45-degree field of view — 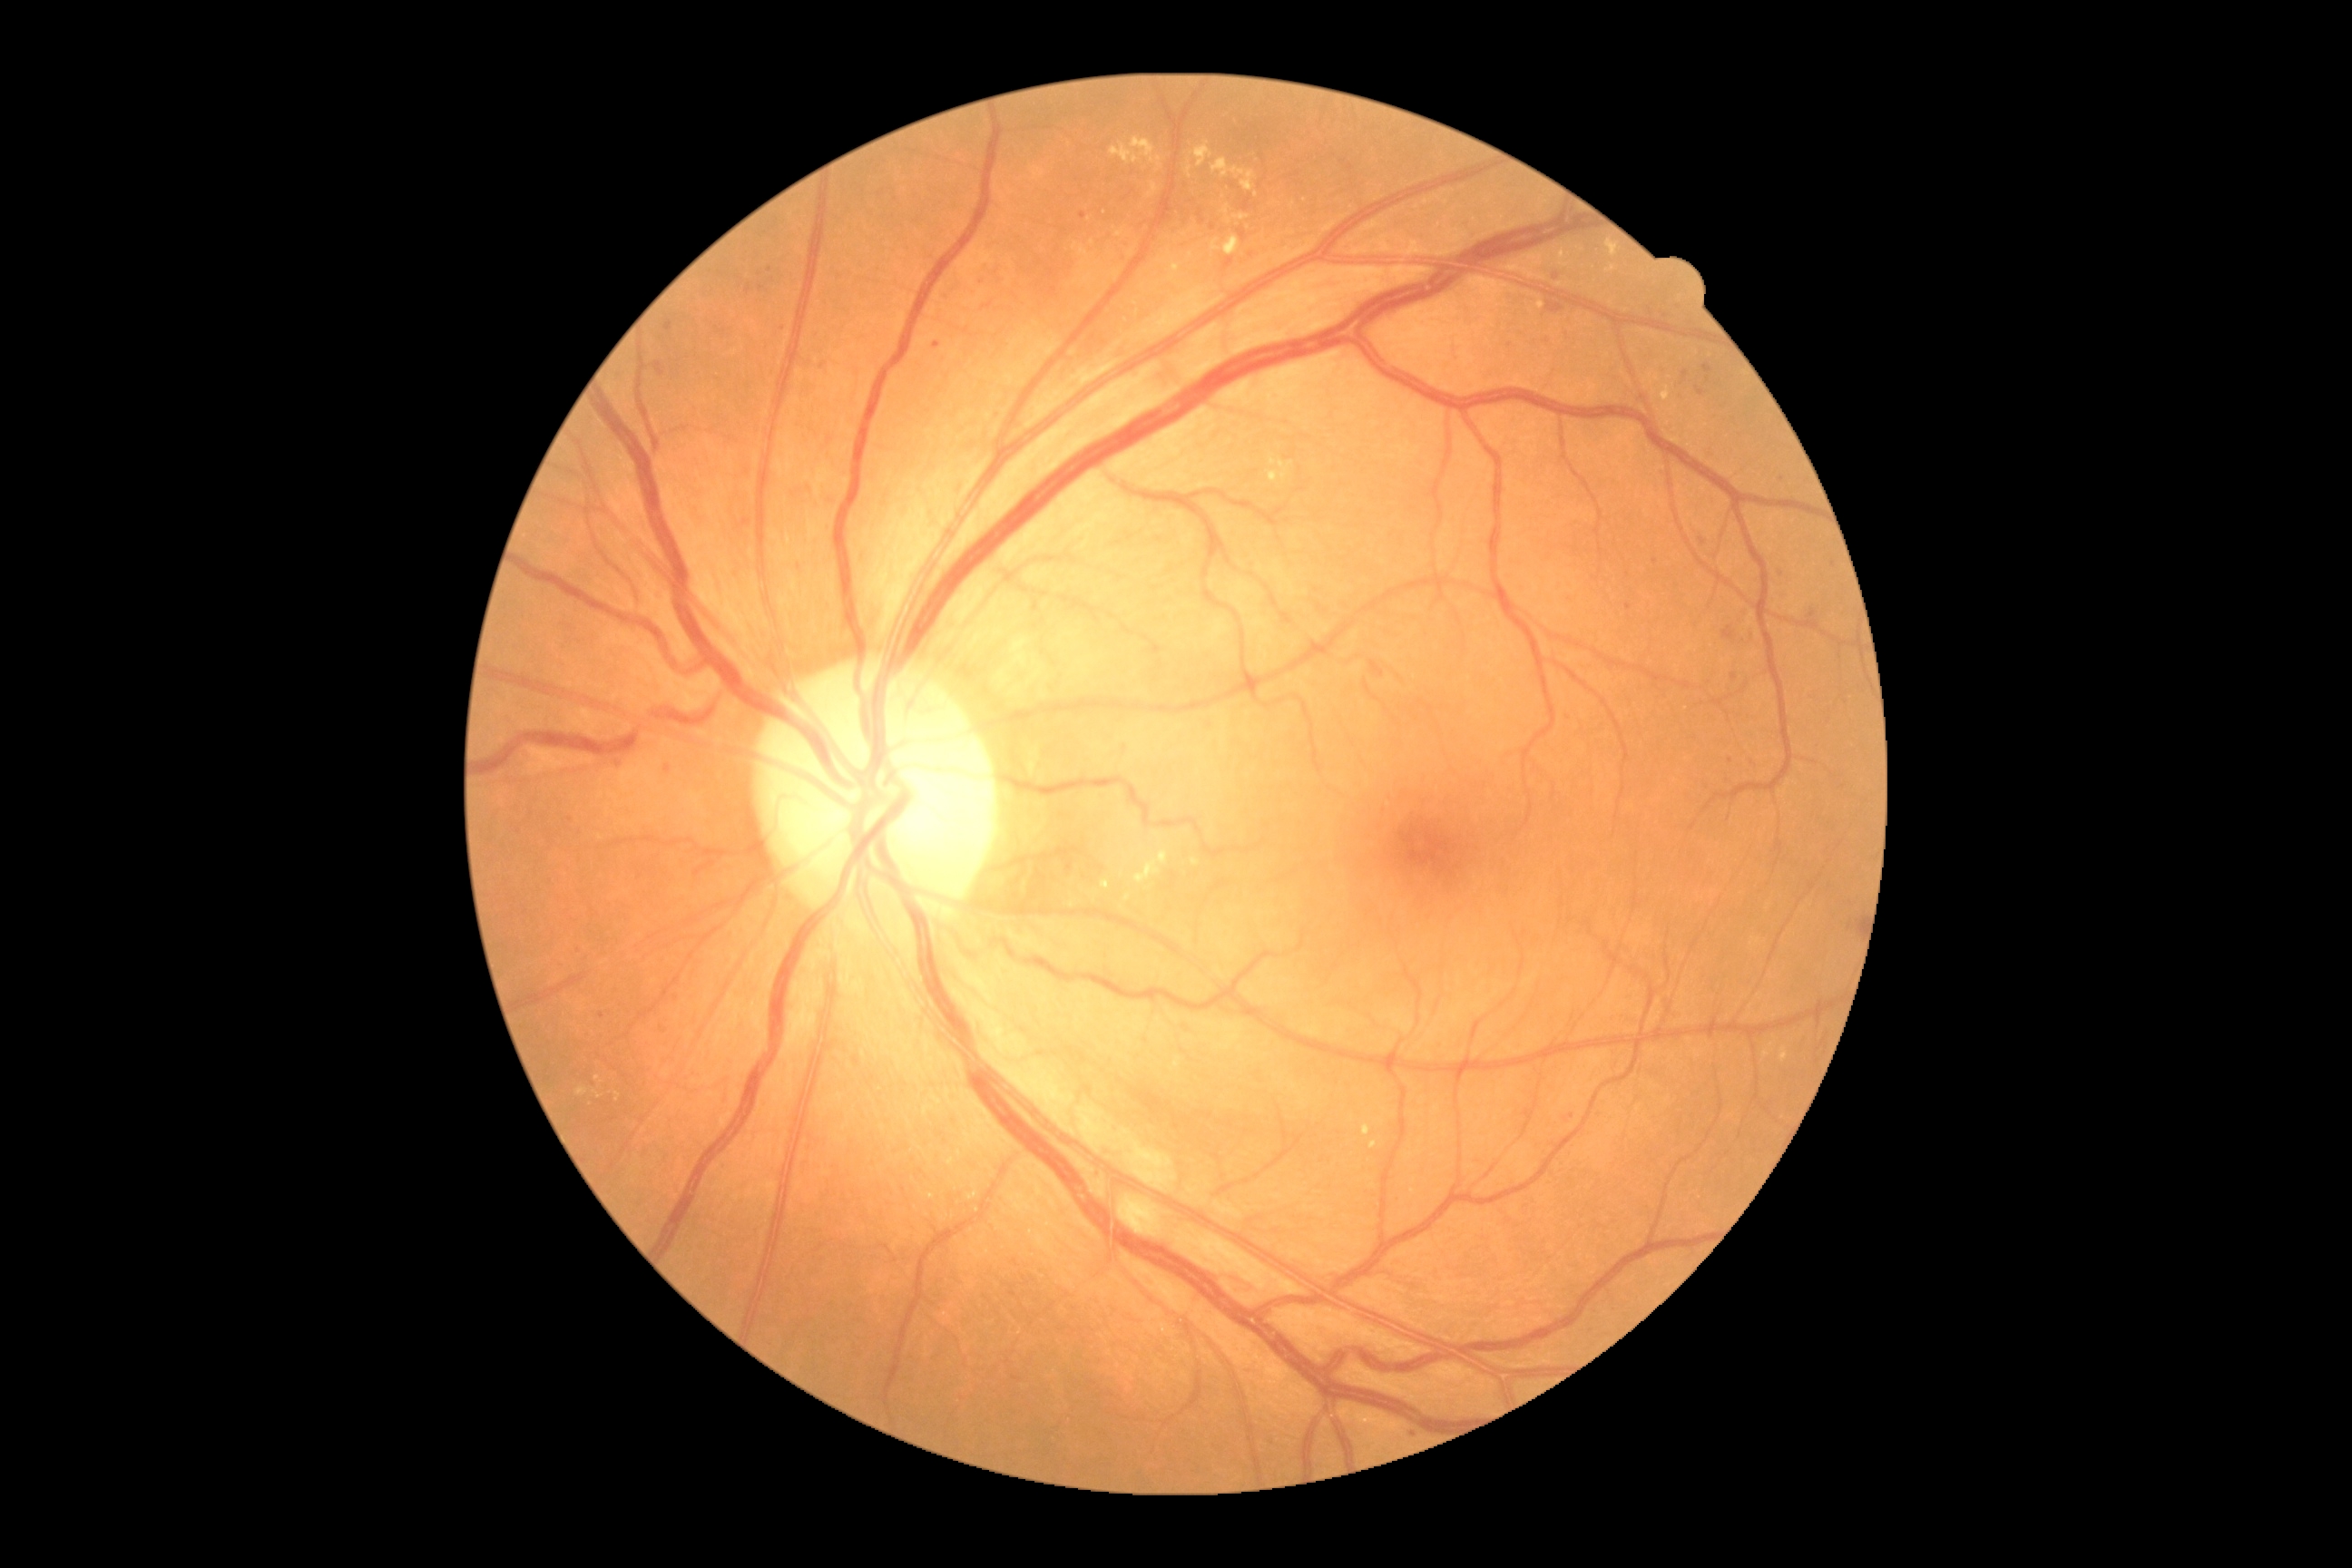

Diabetic retinopathy (DR) is grade 2 — more than just microaneurysms but less than severe NPDR.